512 x 512 pixels. CFP.
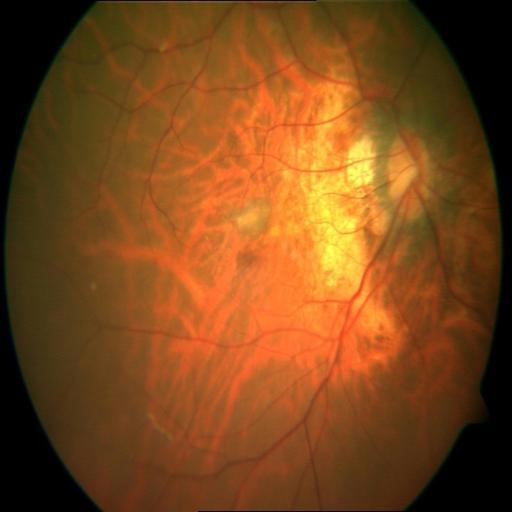 Two findings. Findings consistent with MYA (myopia) and TSLN (tessellation).